DR severity per modified Davis staging: 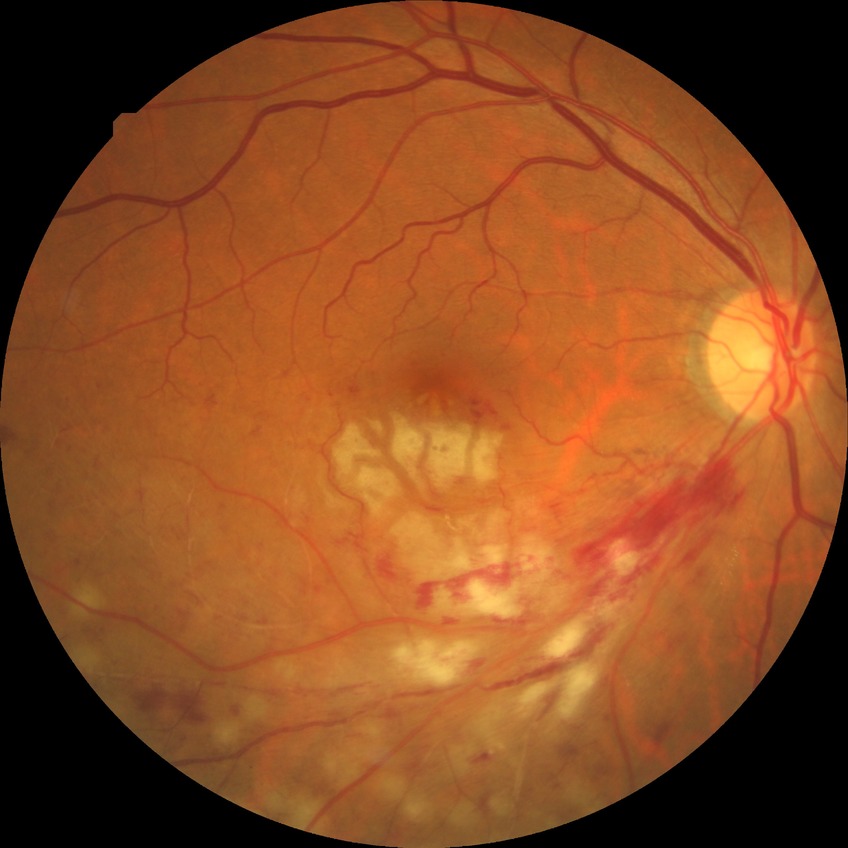 Diabetic retinopathy (DR): no diabetic retinopathy (NDR).